45° field of view; 2352x1568.
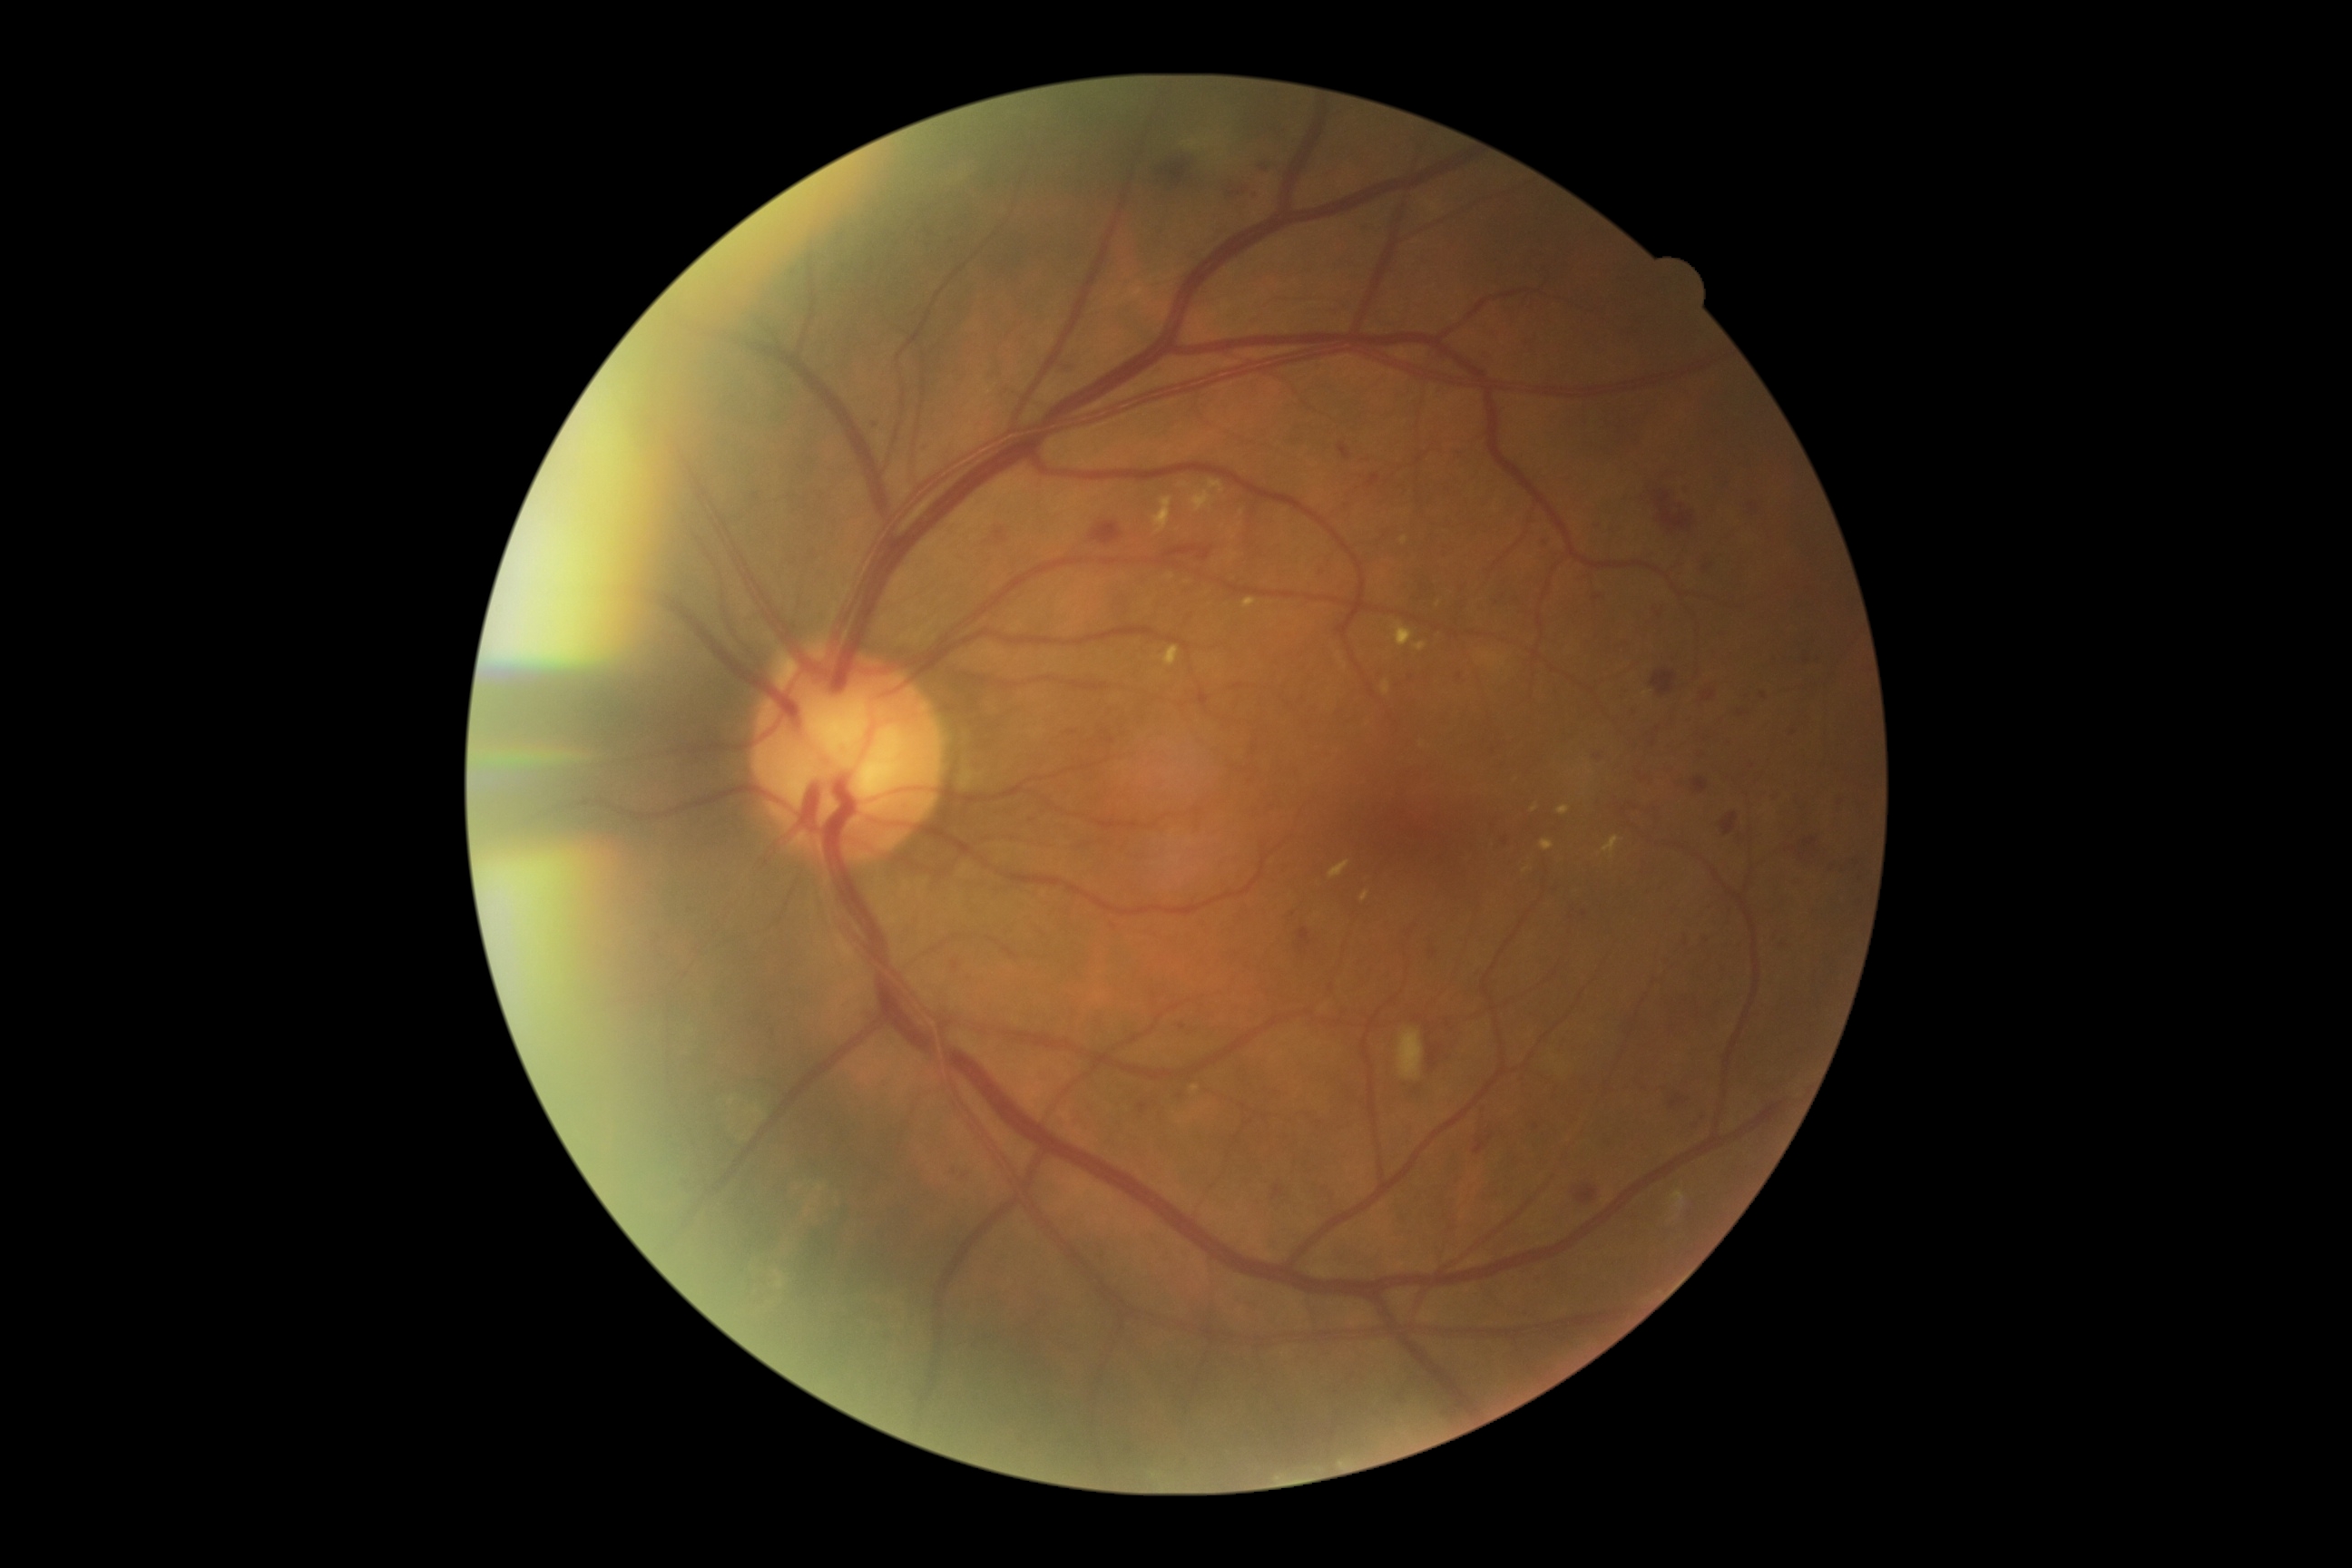
<lesions partial="true">
  <dr_grade>2</dr_grade>
  <ex>(x1=1393, y1=622, x2=1415, y2=647), (x1=1329, y1=861, x2=1351, y2=879), (x1=1362, y1=892, x2=1369, y2=903), (x1=1244, y1=598, x2=1257, y2=609), (x1=1603, y1=836, x2=1620, y2=859), (x1=1542, y1=839, x2=1554, y2=852), (x1=1208, y1=480, x2=1226, y2=495), (x1=1558, y1=805, x2=1571, y2=816), (x1=1402, y1=536, x2=1409, y2=545), (x1=1382, y1=680, x2=1391, y2=696), (x1=1191, y1=1084, x2=1200, y2=1092), (x1=1413, y1=643, x2=1427, y2=652), (x1=1153, y1=498, x2=1171, y2=534), (x1=1161, y1=647, x2=1181, y2=669), (x1=1190, y1=491, x2=1211, y2=513)</ex>
  <ex_small_centers>x=1439 y=604, x=1526 y=871, x=1535 y=808</ex_small_centers>
  <ma partial="true">(x1=1476, y1=607, x2=1484, y2=611), (x1=1542, y1=536, x2=1551, y2=545), (x1=1458, y1=449, x2=1465, y2=458), (x1=1594, y1=596, x2=1602, y2=602), (x1=872, y1=420, x2=879, y2=429), (x1=1139, y1=1102, x2=1148, y2=1115), (x1=1700, y1=750, x2=1709, y2=761), (x1=921, y1=444, x2=926, y2=453)</ma>
  <ma_small_centers>x=1364 y=228, x=1111 y=741, x=1741 y=714, x=1820 y=661, x=1794 y=734, x=1412 y=677, x=1670 y=960, x=1675 y=657, x=1461 y=677, x=1729 y=741, x=1658 y=730</ma_small_centers>
  <se>(x1=1398, y1=1030, x2=1424, y2=1079)</se>
  <he partial="true">(x1=1273, y1=1186, x2=1284, y2=1200), (x1=1631, y1=480, x2=1696, y2=536), (x1=1700, y1=558, x2=1714, y2=573), (x1=1230, y1=188, x2=1248, y2=197), (x1=1649, y1=732, x2=1658, y2=743), (x1=1651, y1=671, x2=1678, y2=696), (x1=1645, y1=769, x2=1654, y2=781), (x1=1652, y1=605, x2=1667, y2=614), (x1=1721, y1=812, x2=1738, y2=836), (x1=1260, y1=161, x2=1268, y2=170), (x1=1057, y1=364, x2=1070, y2=373), (x1=1367, y1=475, x2=1380, y2=489), (x1=1155, y1=545, x2=1213, y2=565), (x1=1475, y1=1139, x2=1487, y2=1155), (x1=1573, y1=1181, x2=1605, y2=1204), (x1=1692, y1=750, x2=1705, y2=758), (x1=997, y1=531, x2=1006, y2=542), (x1=1703, y1=691, x2=1716, y2=701), (x1=1298, y1=928, x2=1311, y2=948)</he>
</lesions>